62 years old; visual field mean defect (MD): -2.65 dB; non-mydriatic acquisition: 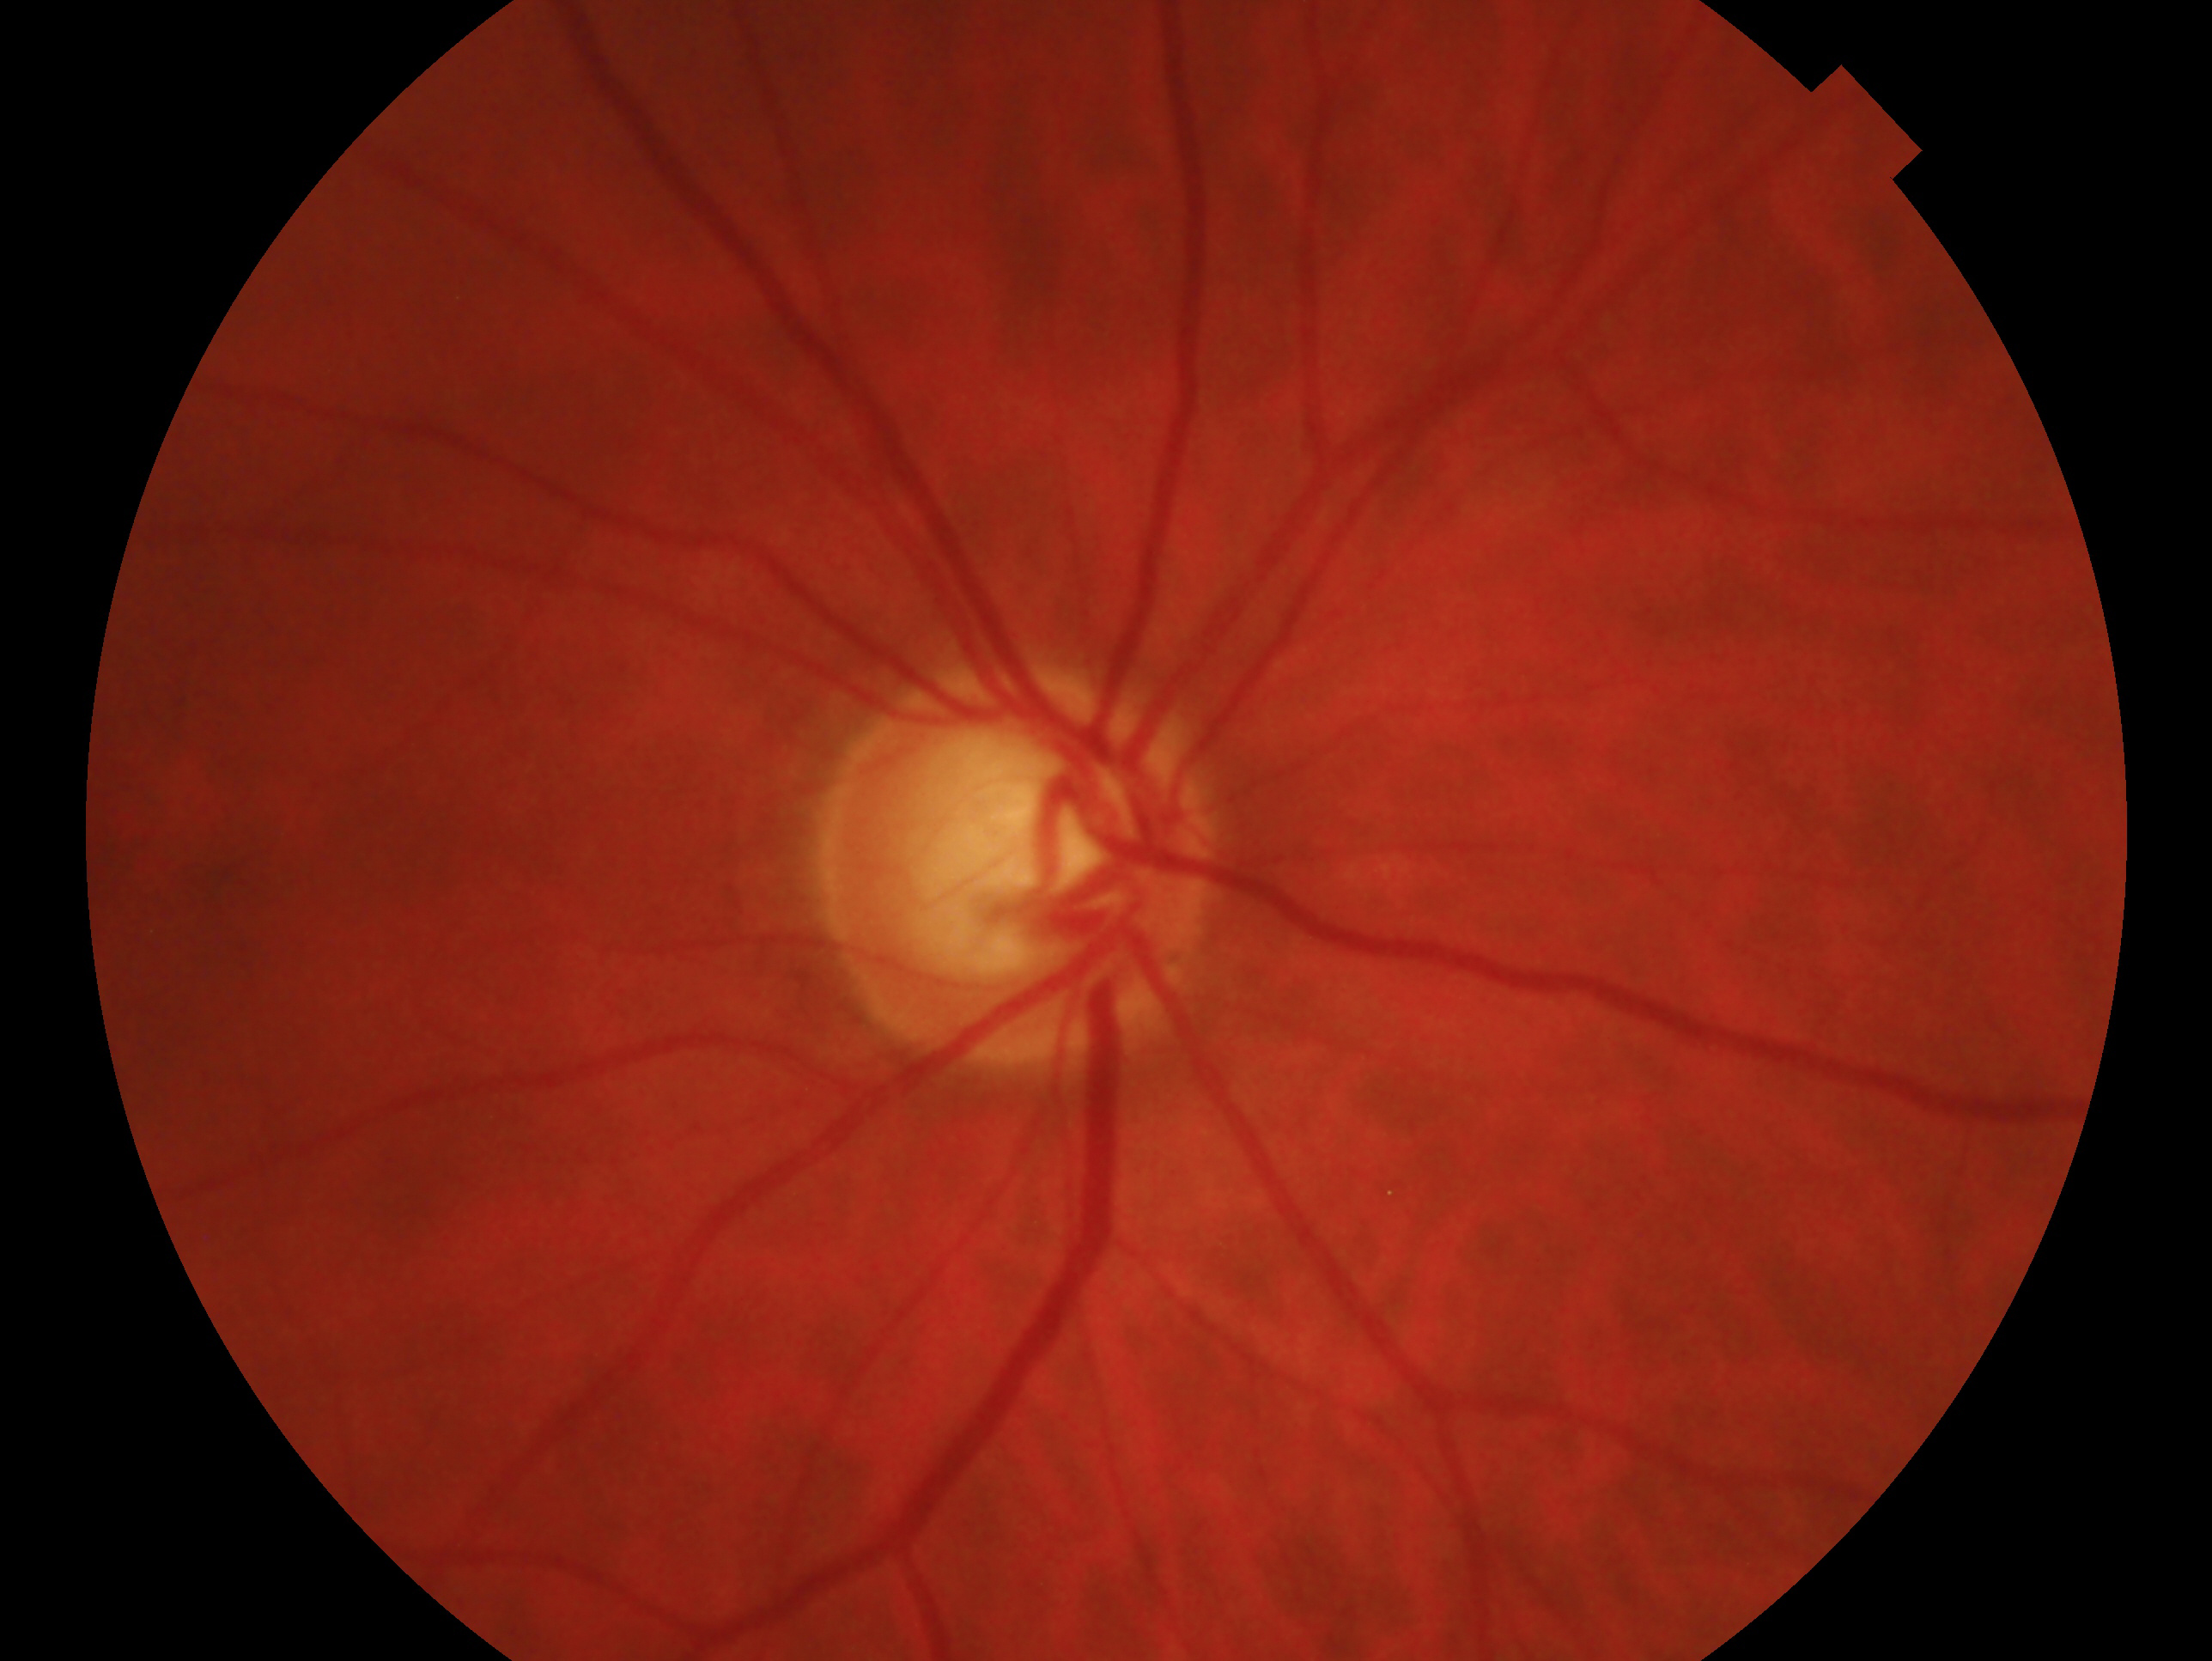
{
  "glaucoma_dx": "glaucomatous optic neuropathy",
  "eye": "oculus dexter"
}